Graded on the modified Davis scale — 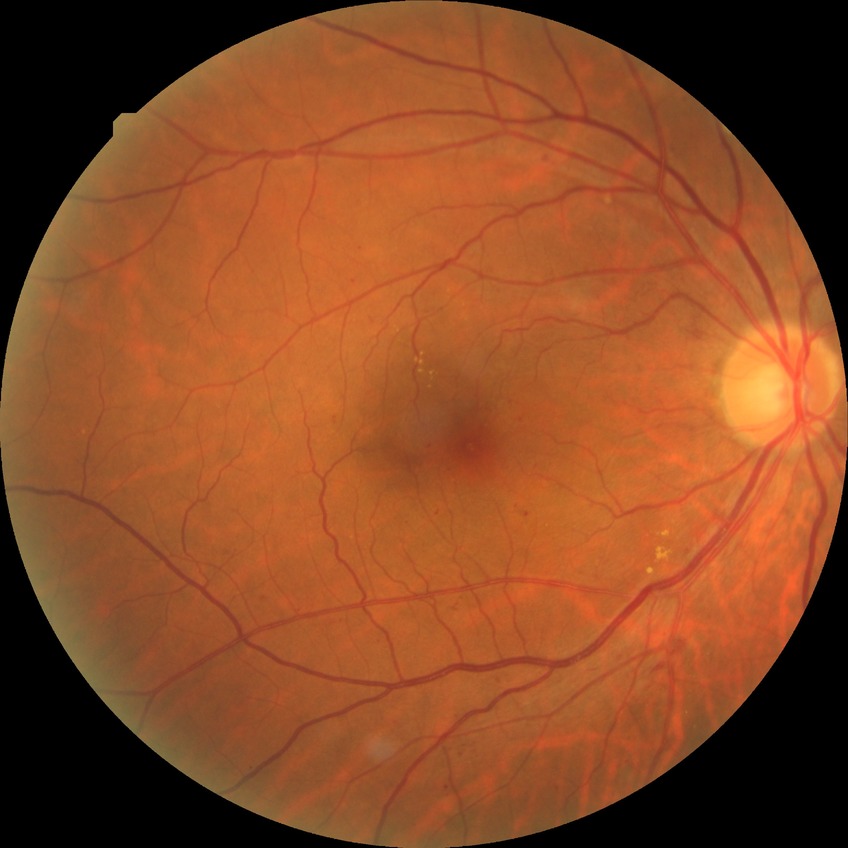

The retinopathy is classified as non-proliferative diabetic retinopathy.
Diabetic retinopathy (DR) is SDR (simple diabetic retinopathy).